Image size 848x848. CFP. DR severity per modified Davis staging:
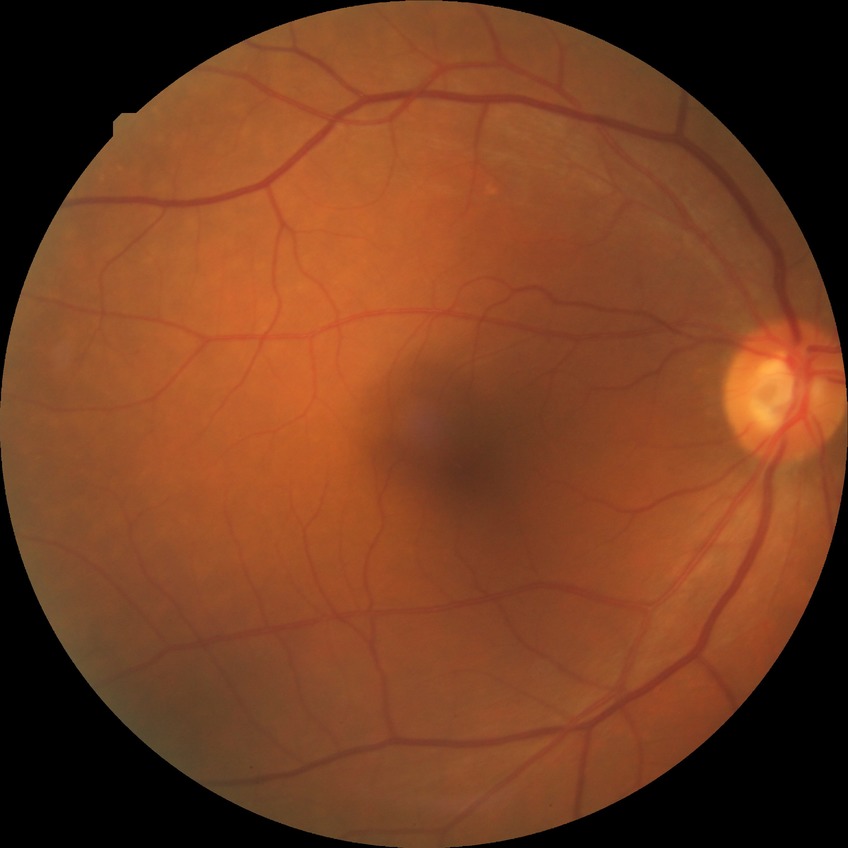

Diabetic retinopathy (DR): no diabetic retinopathy (NDR).